CFP, acquired with a Topcon TRC-NW8 — 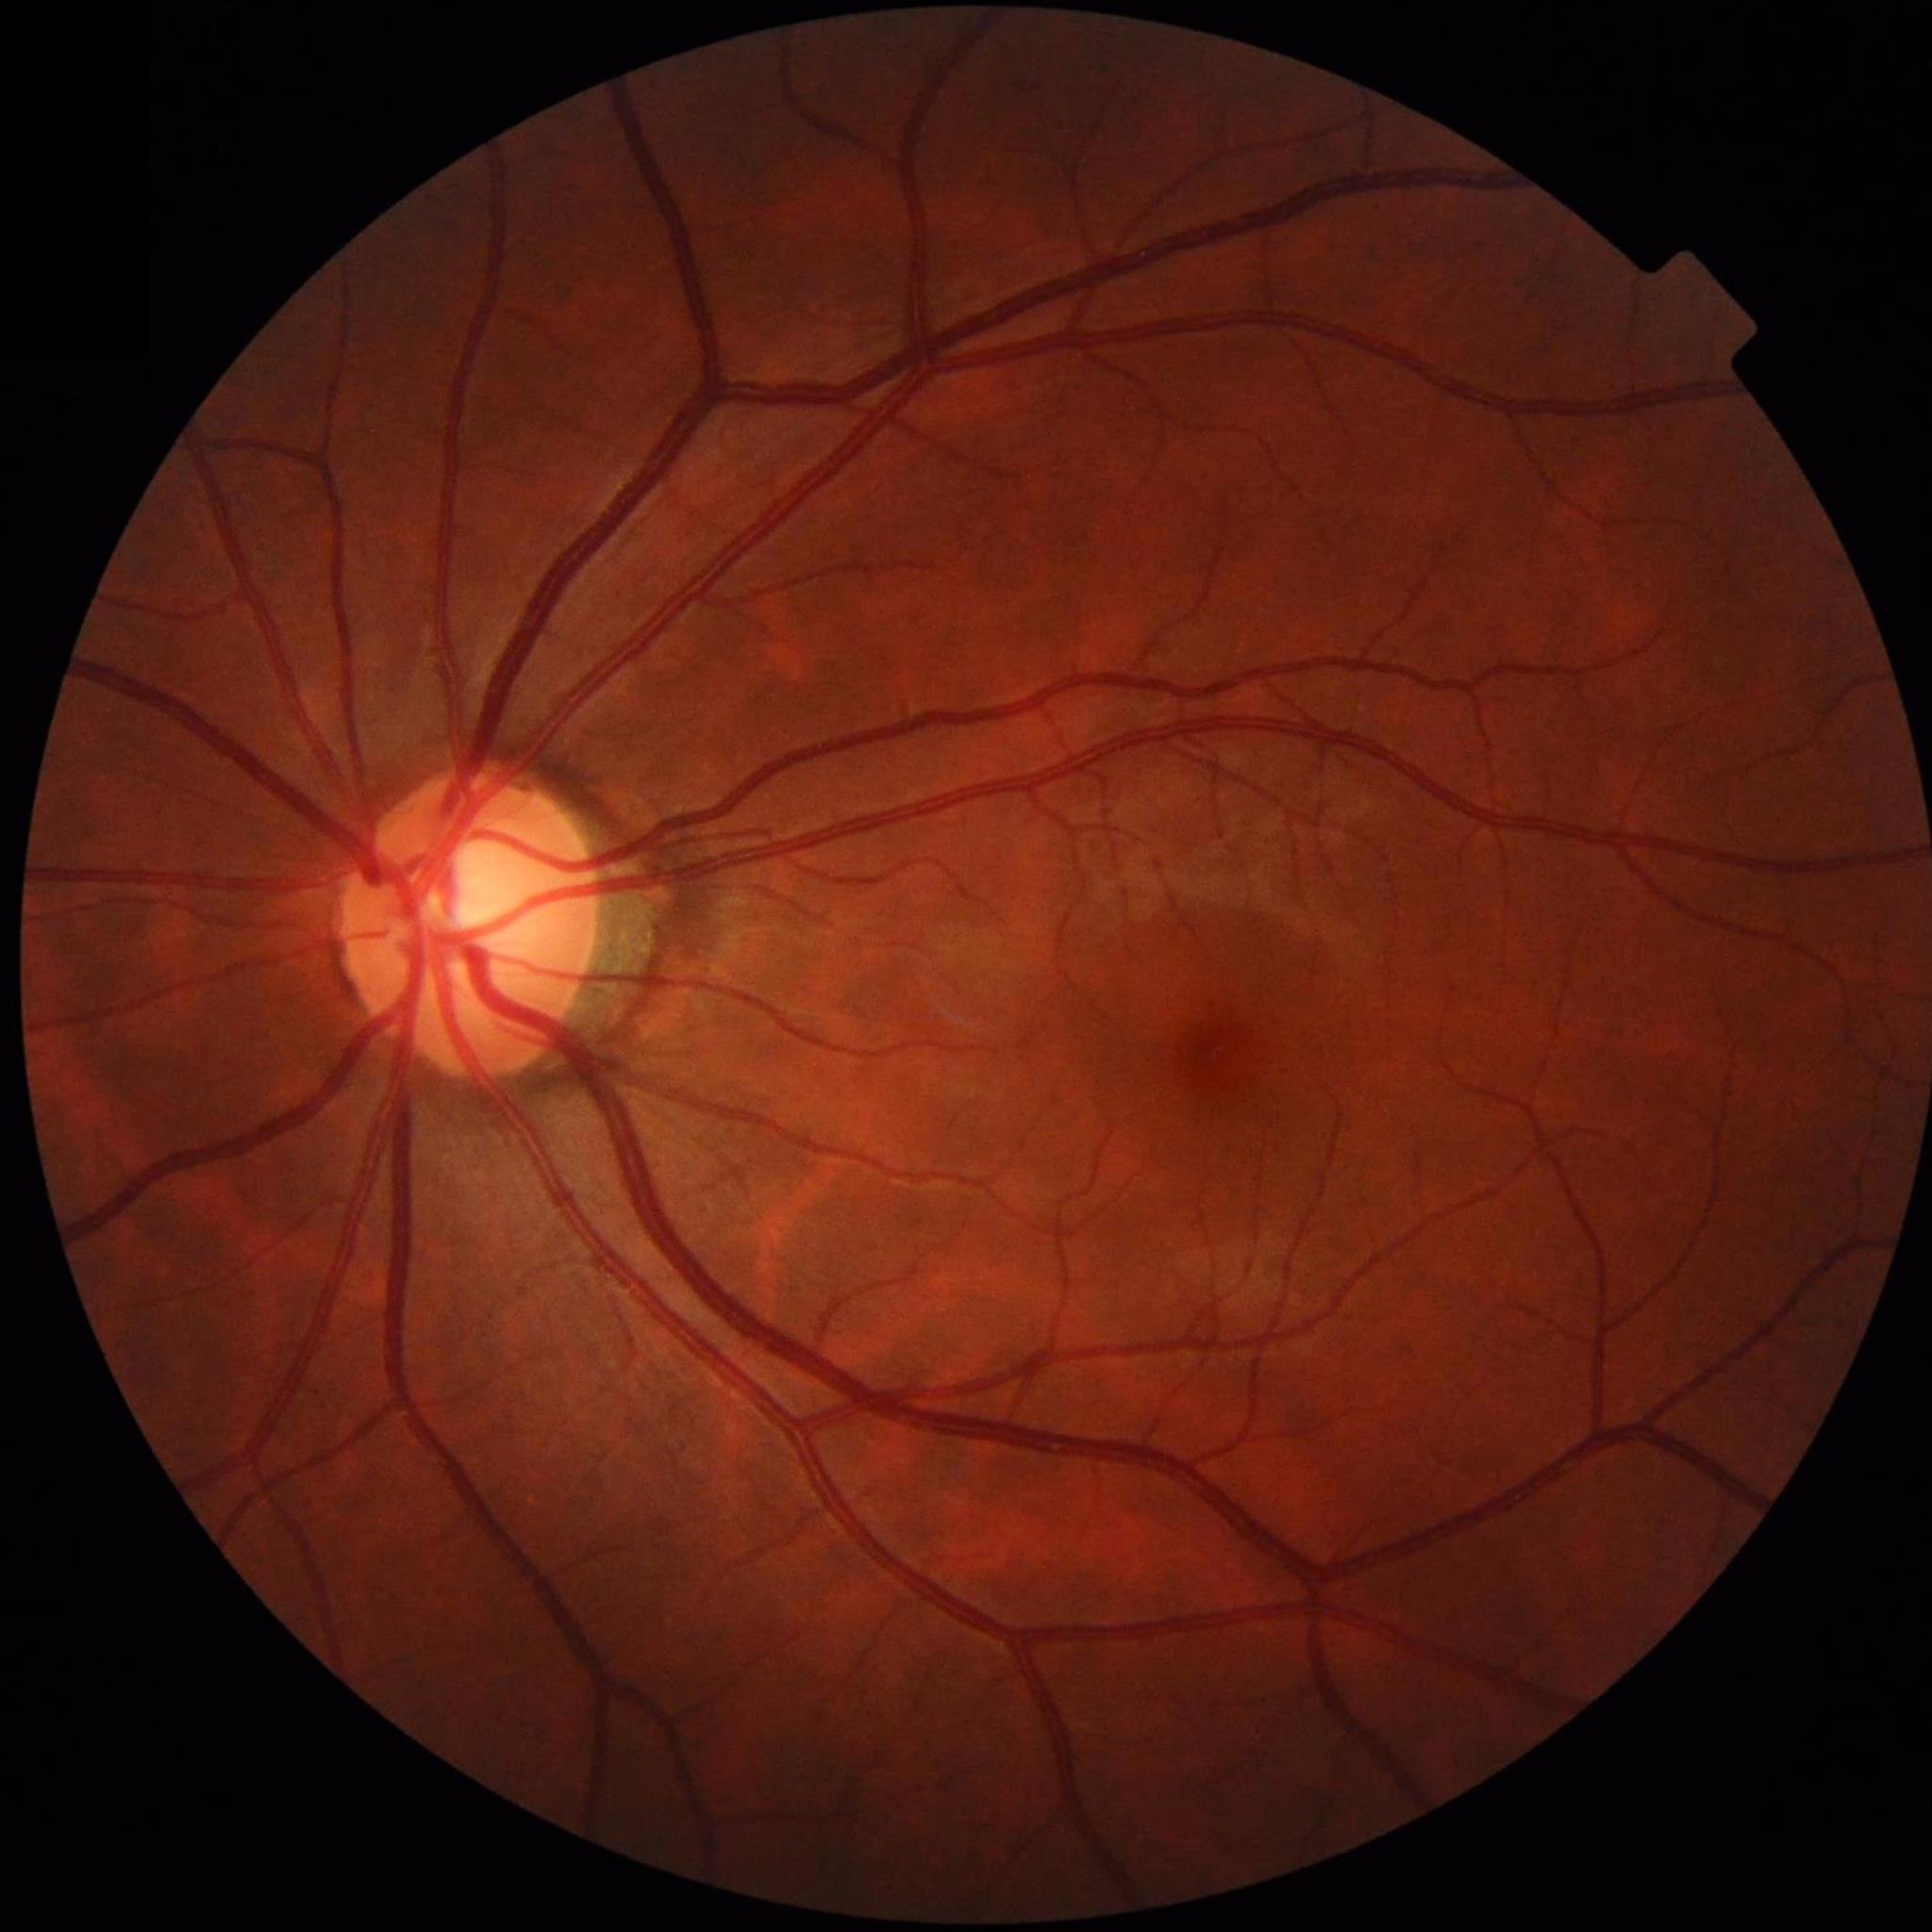

Impression: control (no AMD/DR/glaucoma).